Captured on a Kowa VX-10α fundus camera, fundus photo, 50° FOV
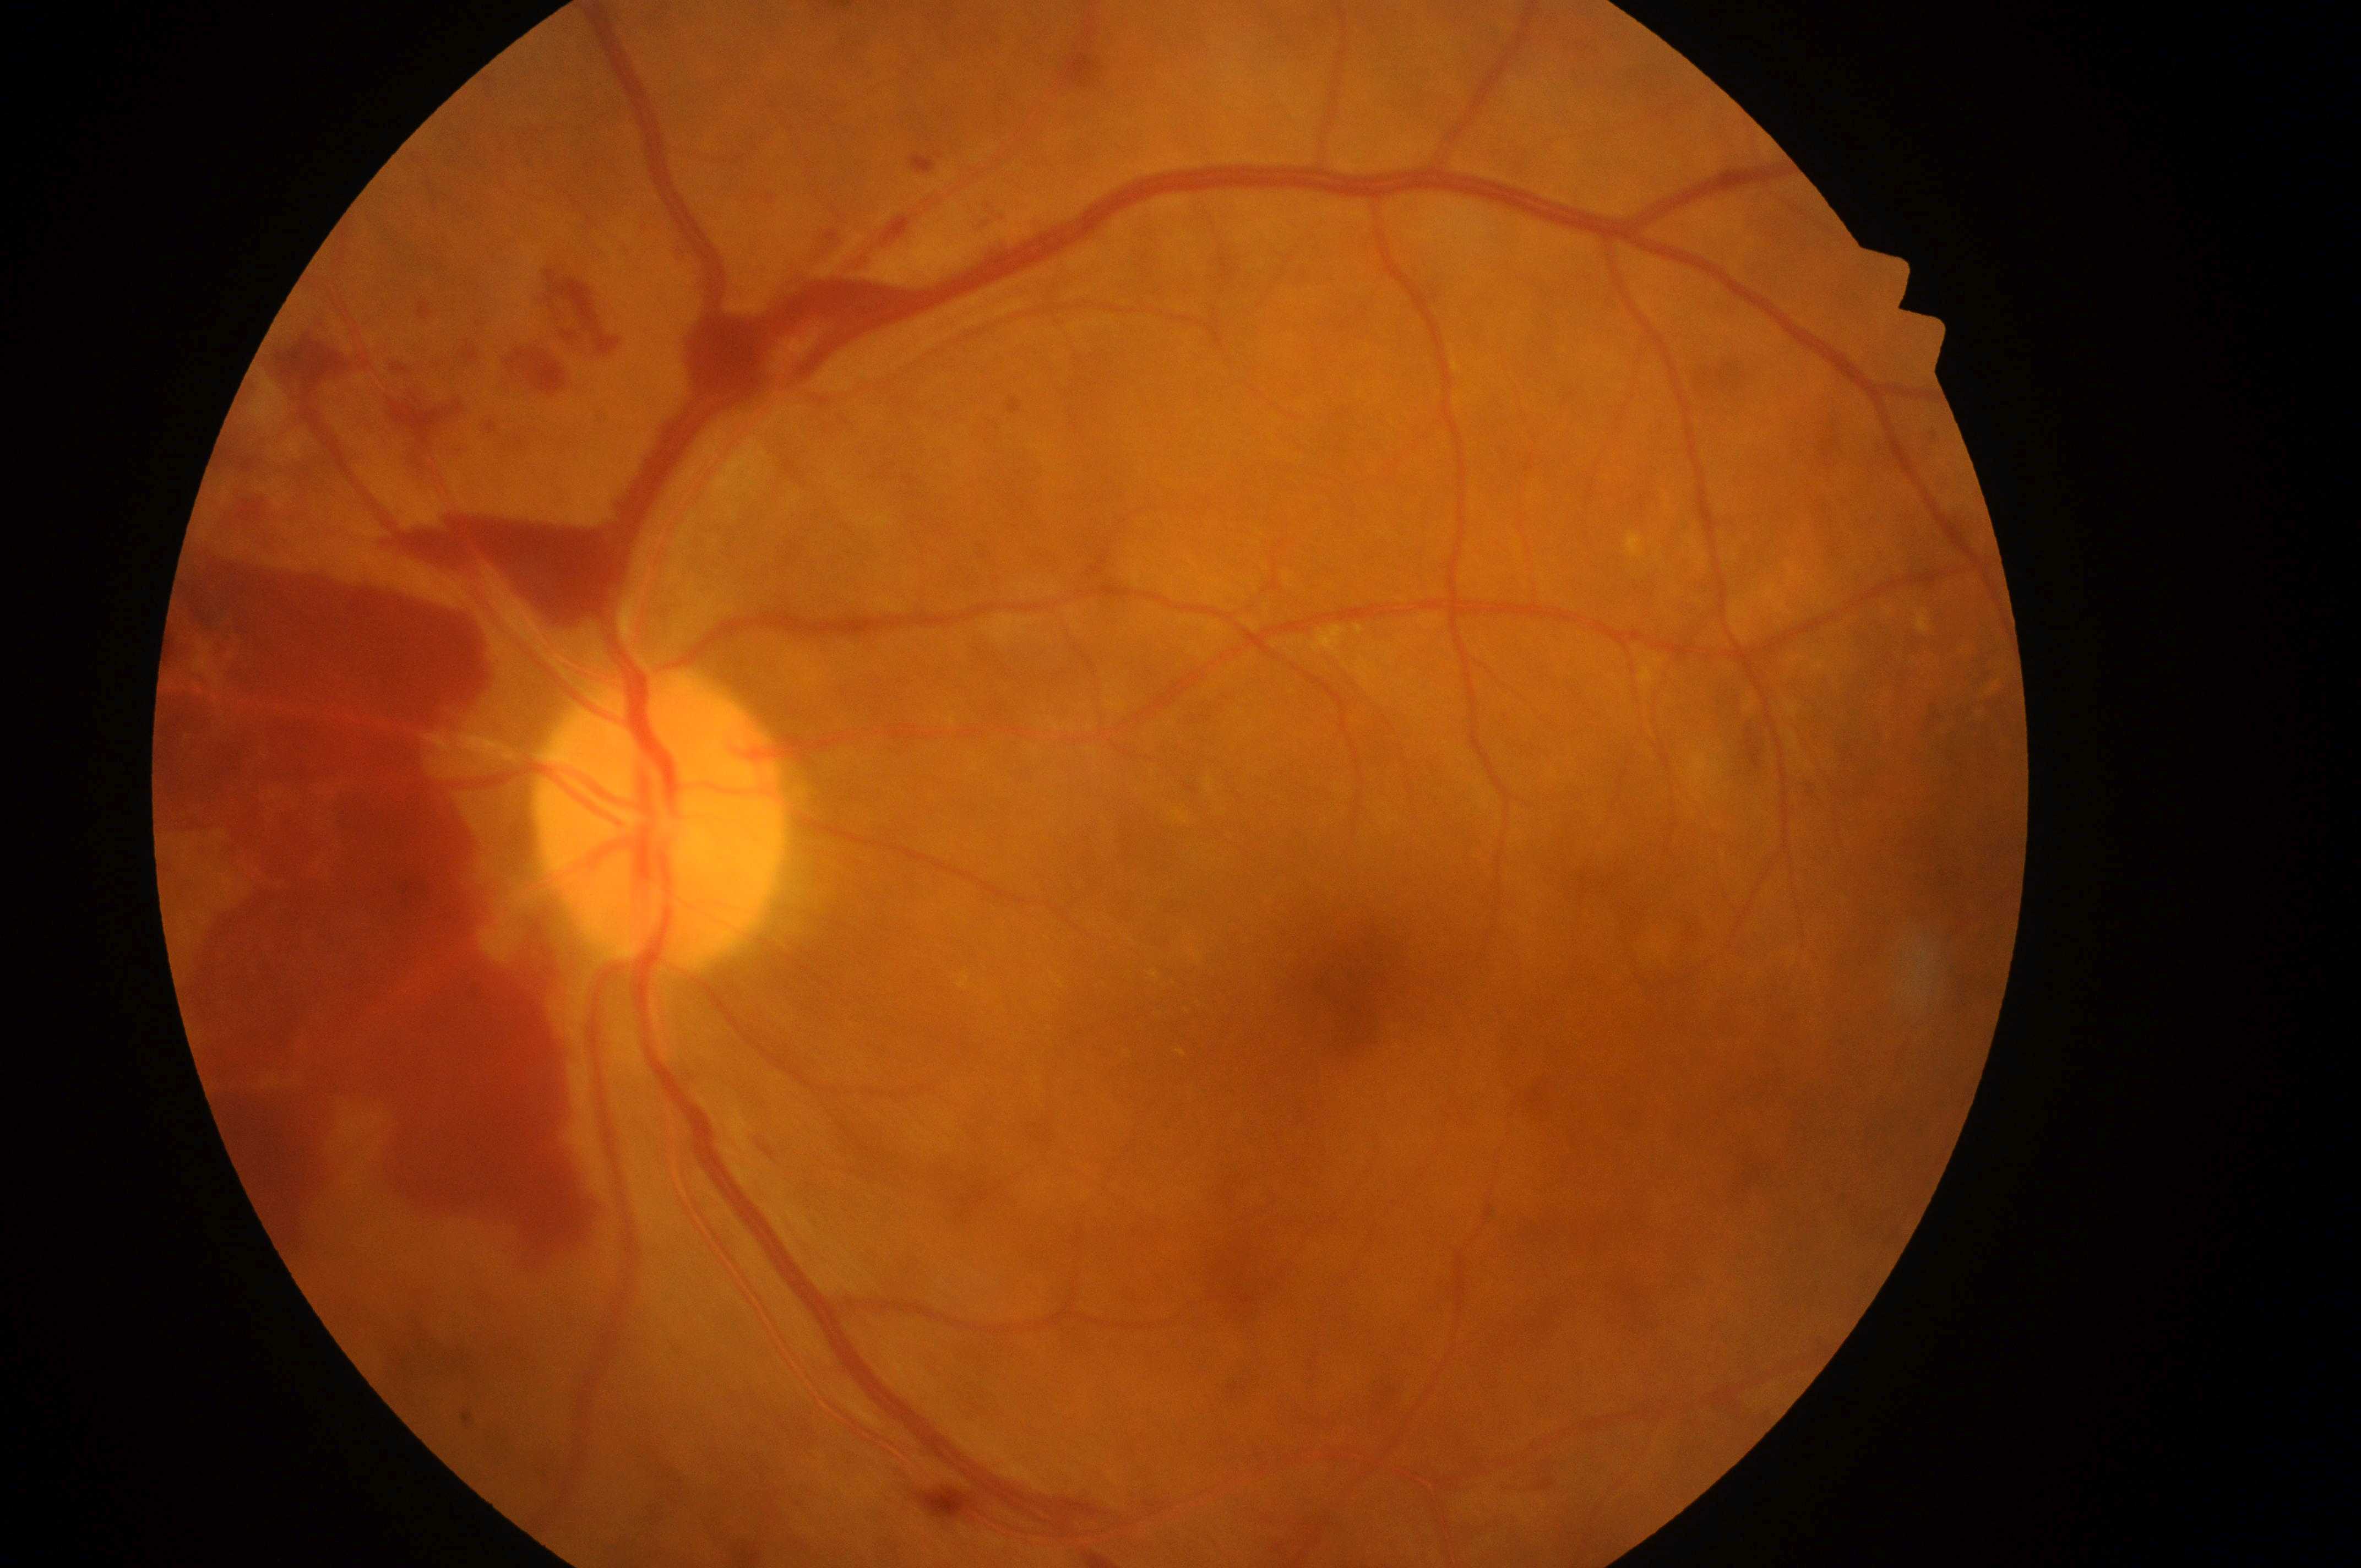
diabetic macular edema (DME): 2/2
ONH: 654px, 837px
DR class: proliferative diabetic retinopathy
diabetic retinopathy (DR): 4
the fovea: 1357px, 996px
eye: OS